Fundus photograph cropped around the optic nerve head:
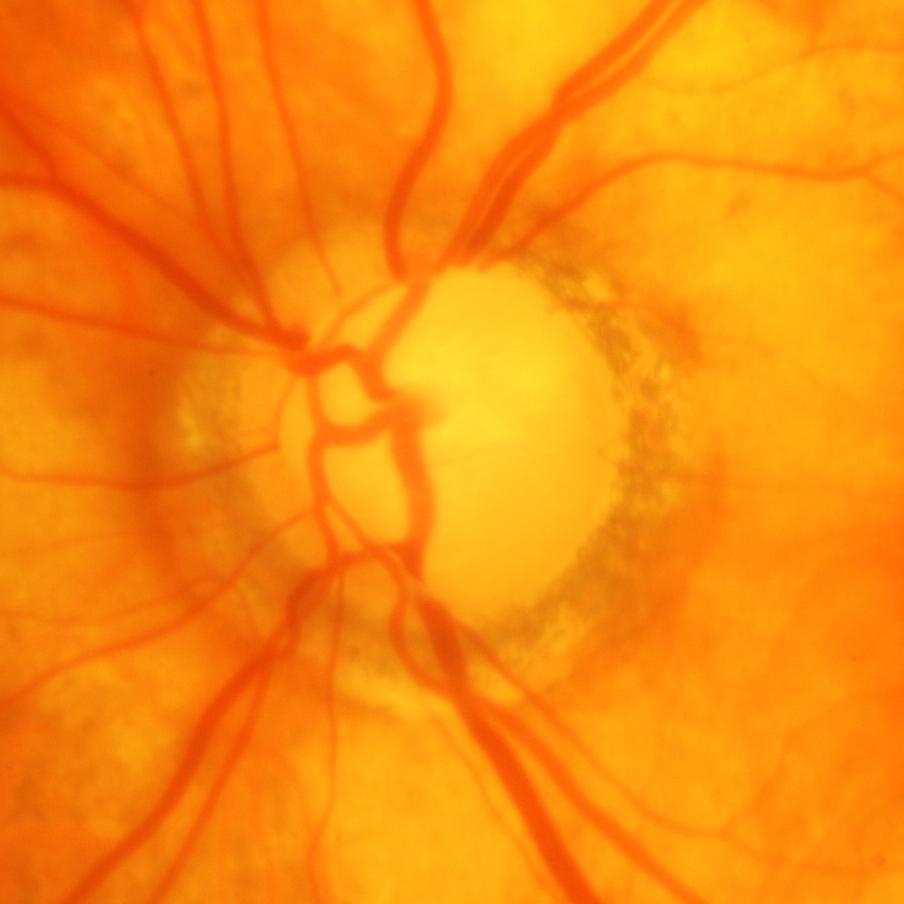

Q: What is the glaucoma diagnosis?
A: Yes — glaucomatous changes.